Acquired with a NIDEK AFC-230 · color fundus photograph · modified Davis grading:
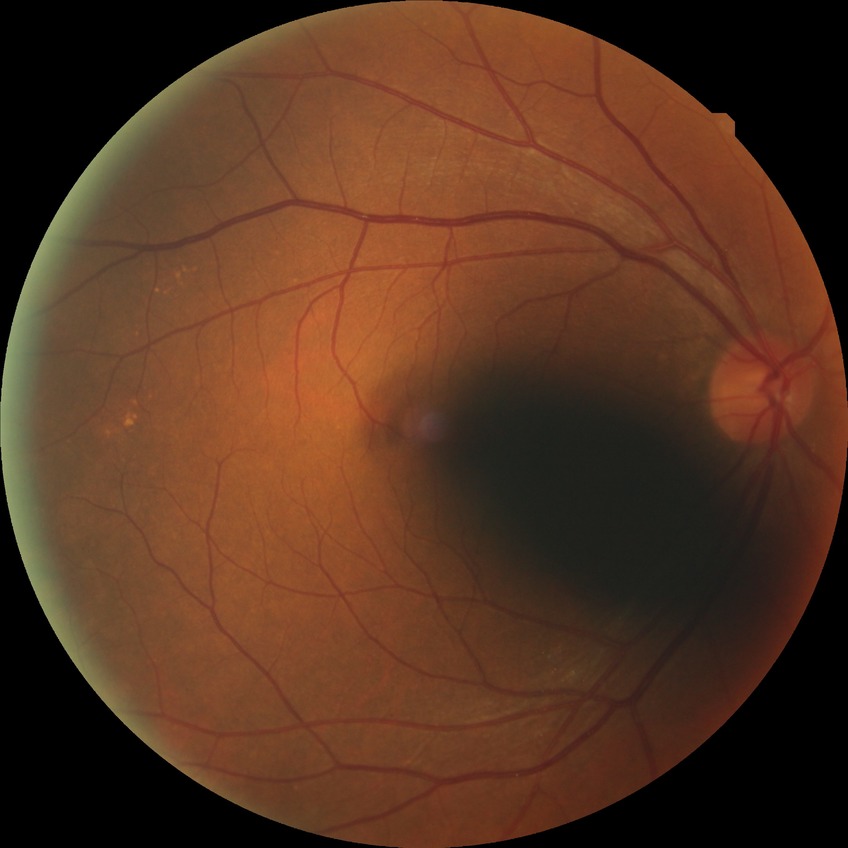
DR severity is NDR.